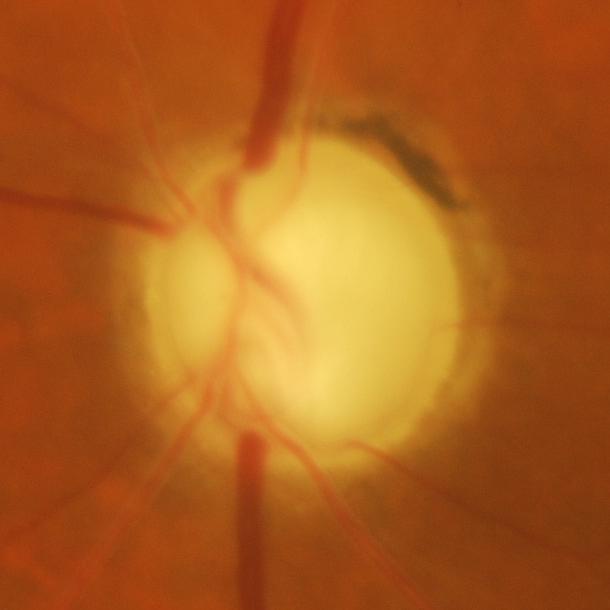
Glaucomatous findings.